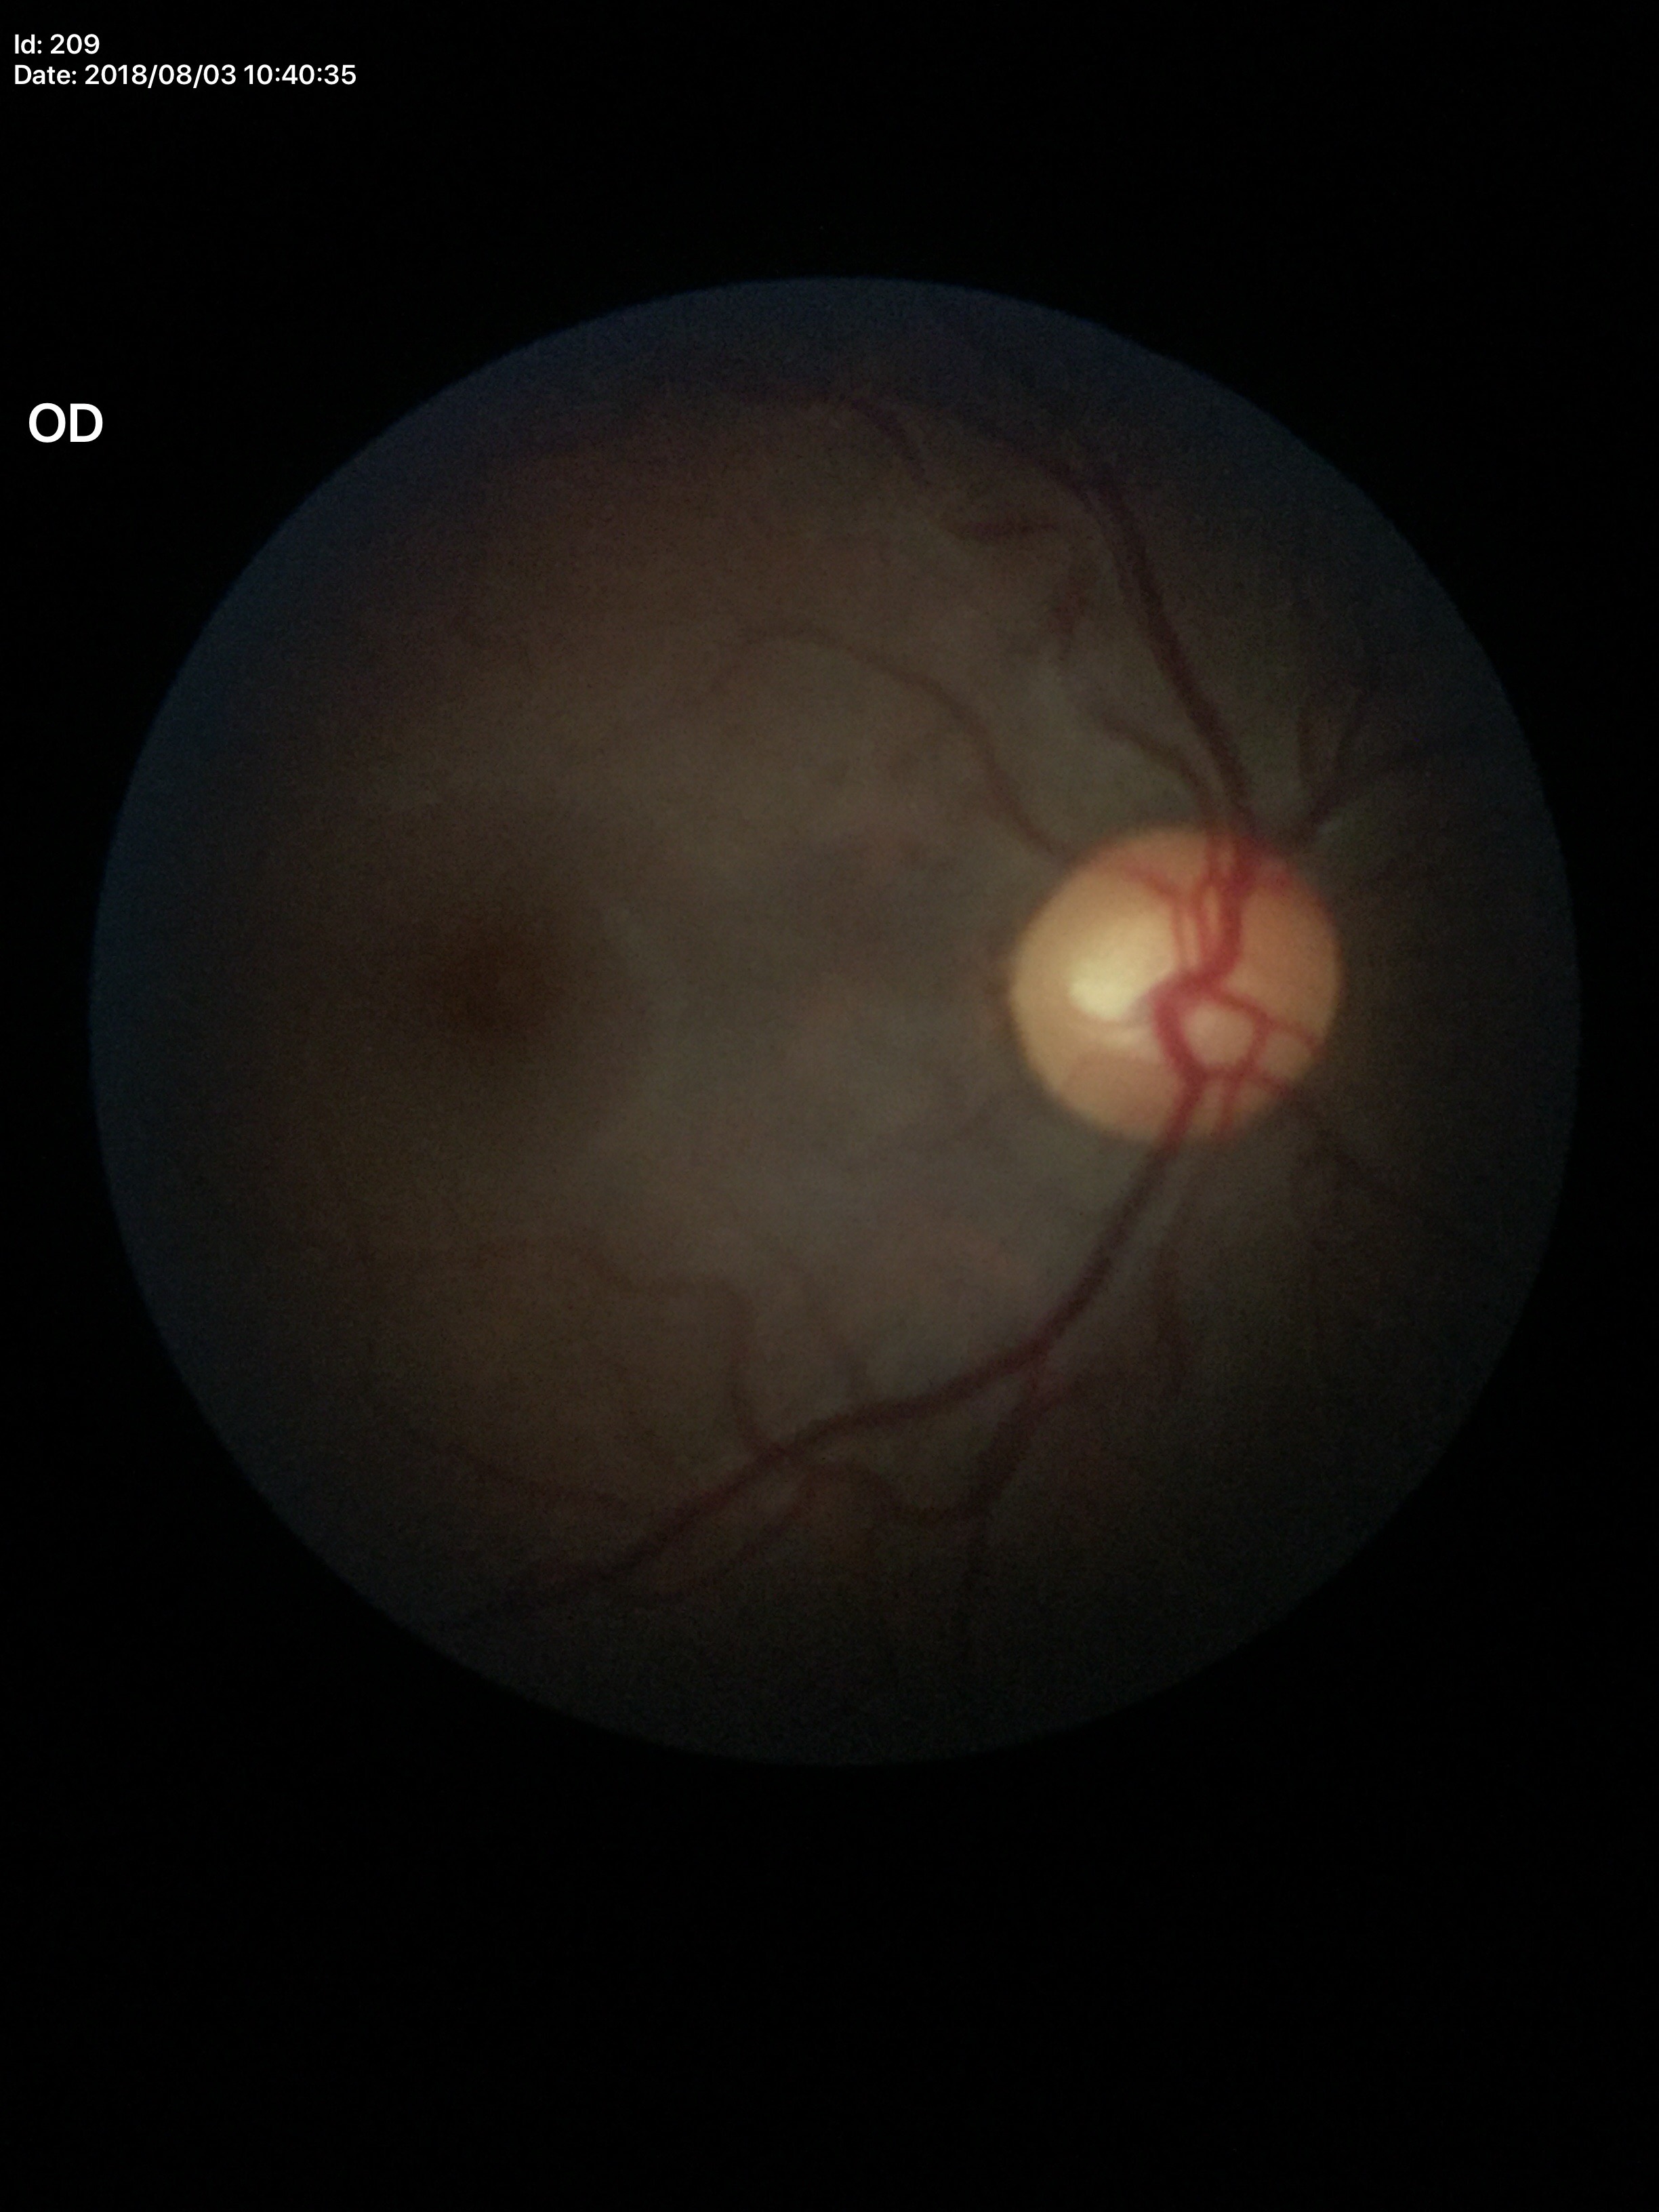
Negative for glaucoma suspicion.
Vertical cup-to-disc ratio (VCDR) of 0.50.